NIDEK AFC-230: 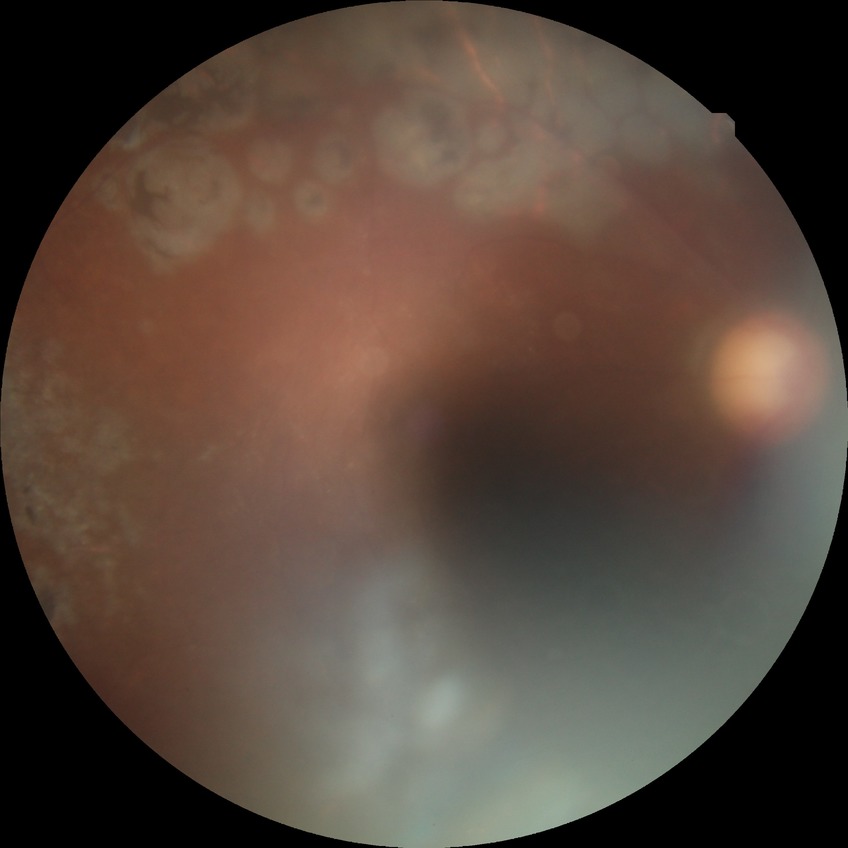 Diabetic retinopathy (DR) is PDR (proliferative diabetic retinopathy).